Fundus photo; 45° FOV; 2352 by 1568 pixels: 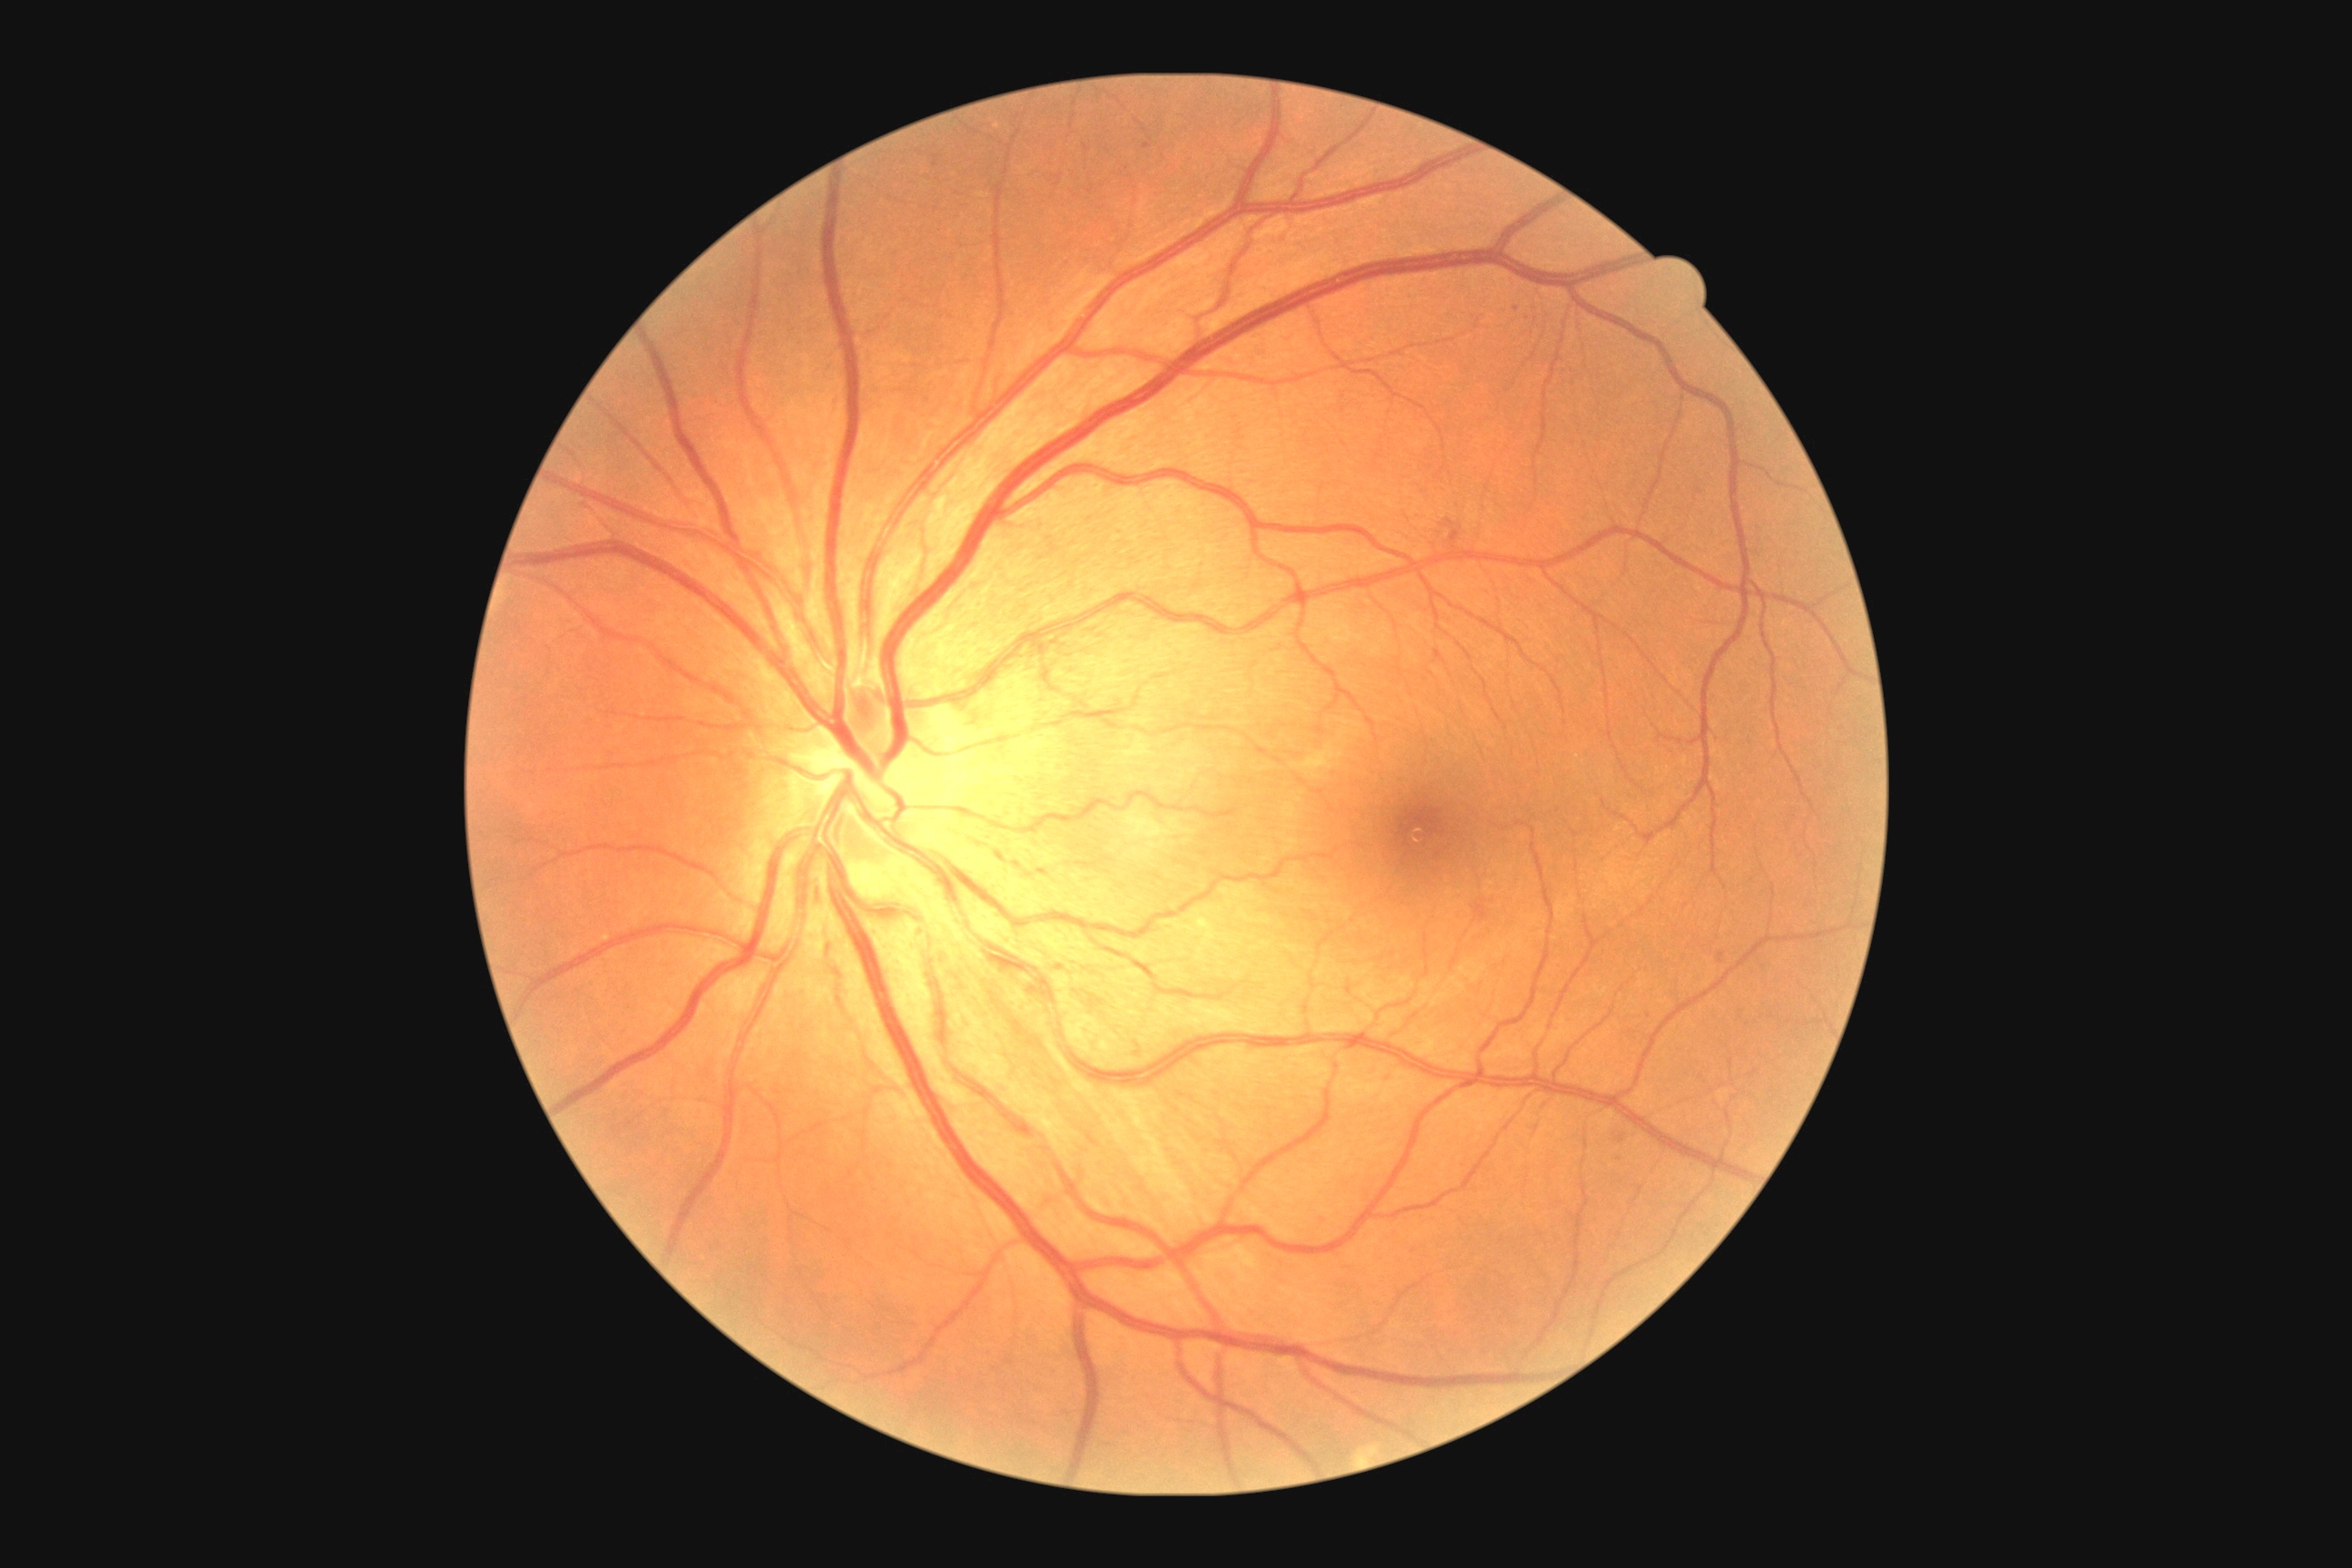 diabetic retinopathy grade@2, DR class@non-proliferative diabetic retinopathy.